Image size 2102x1736. Color fundus image: 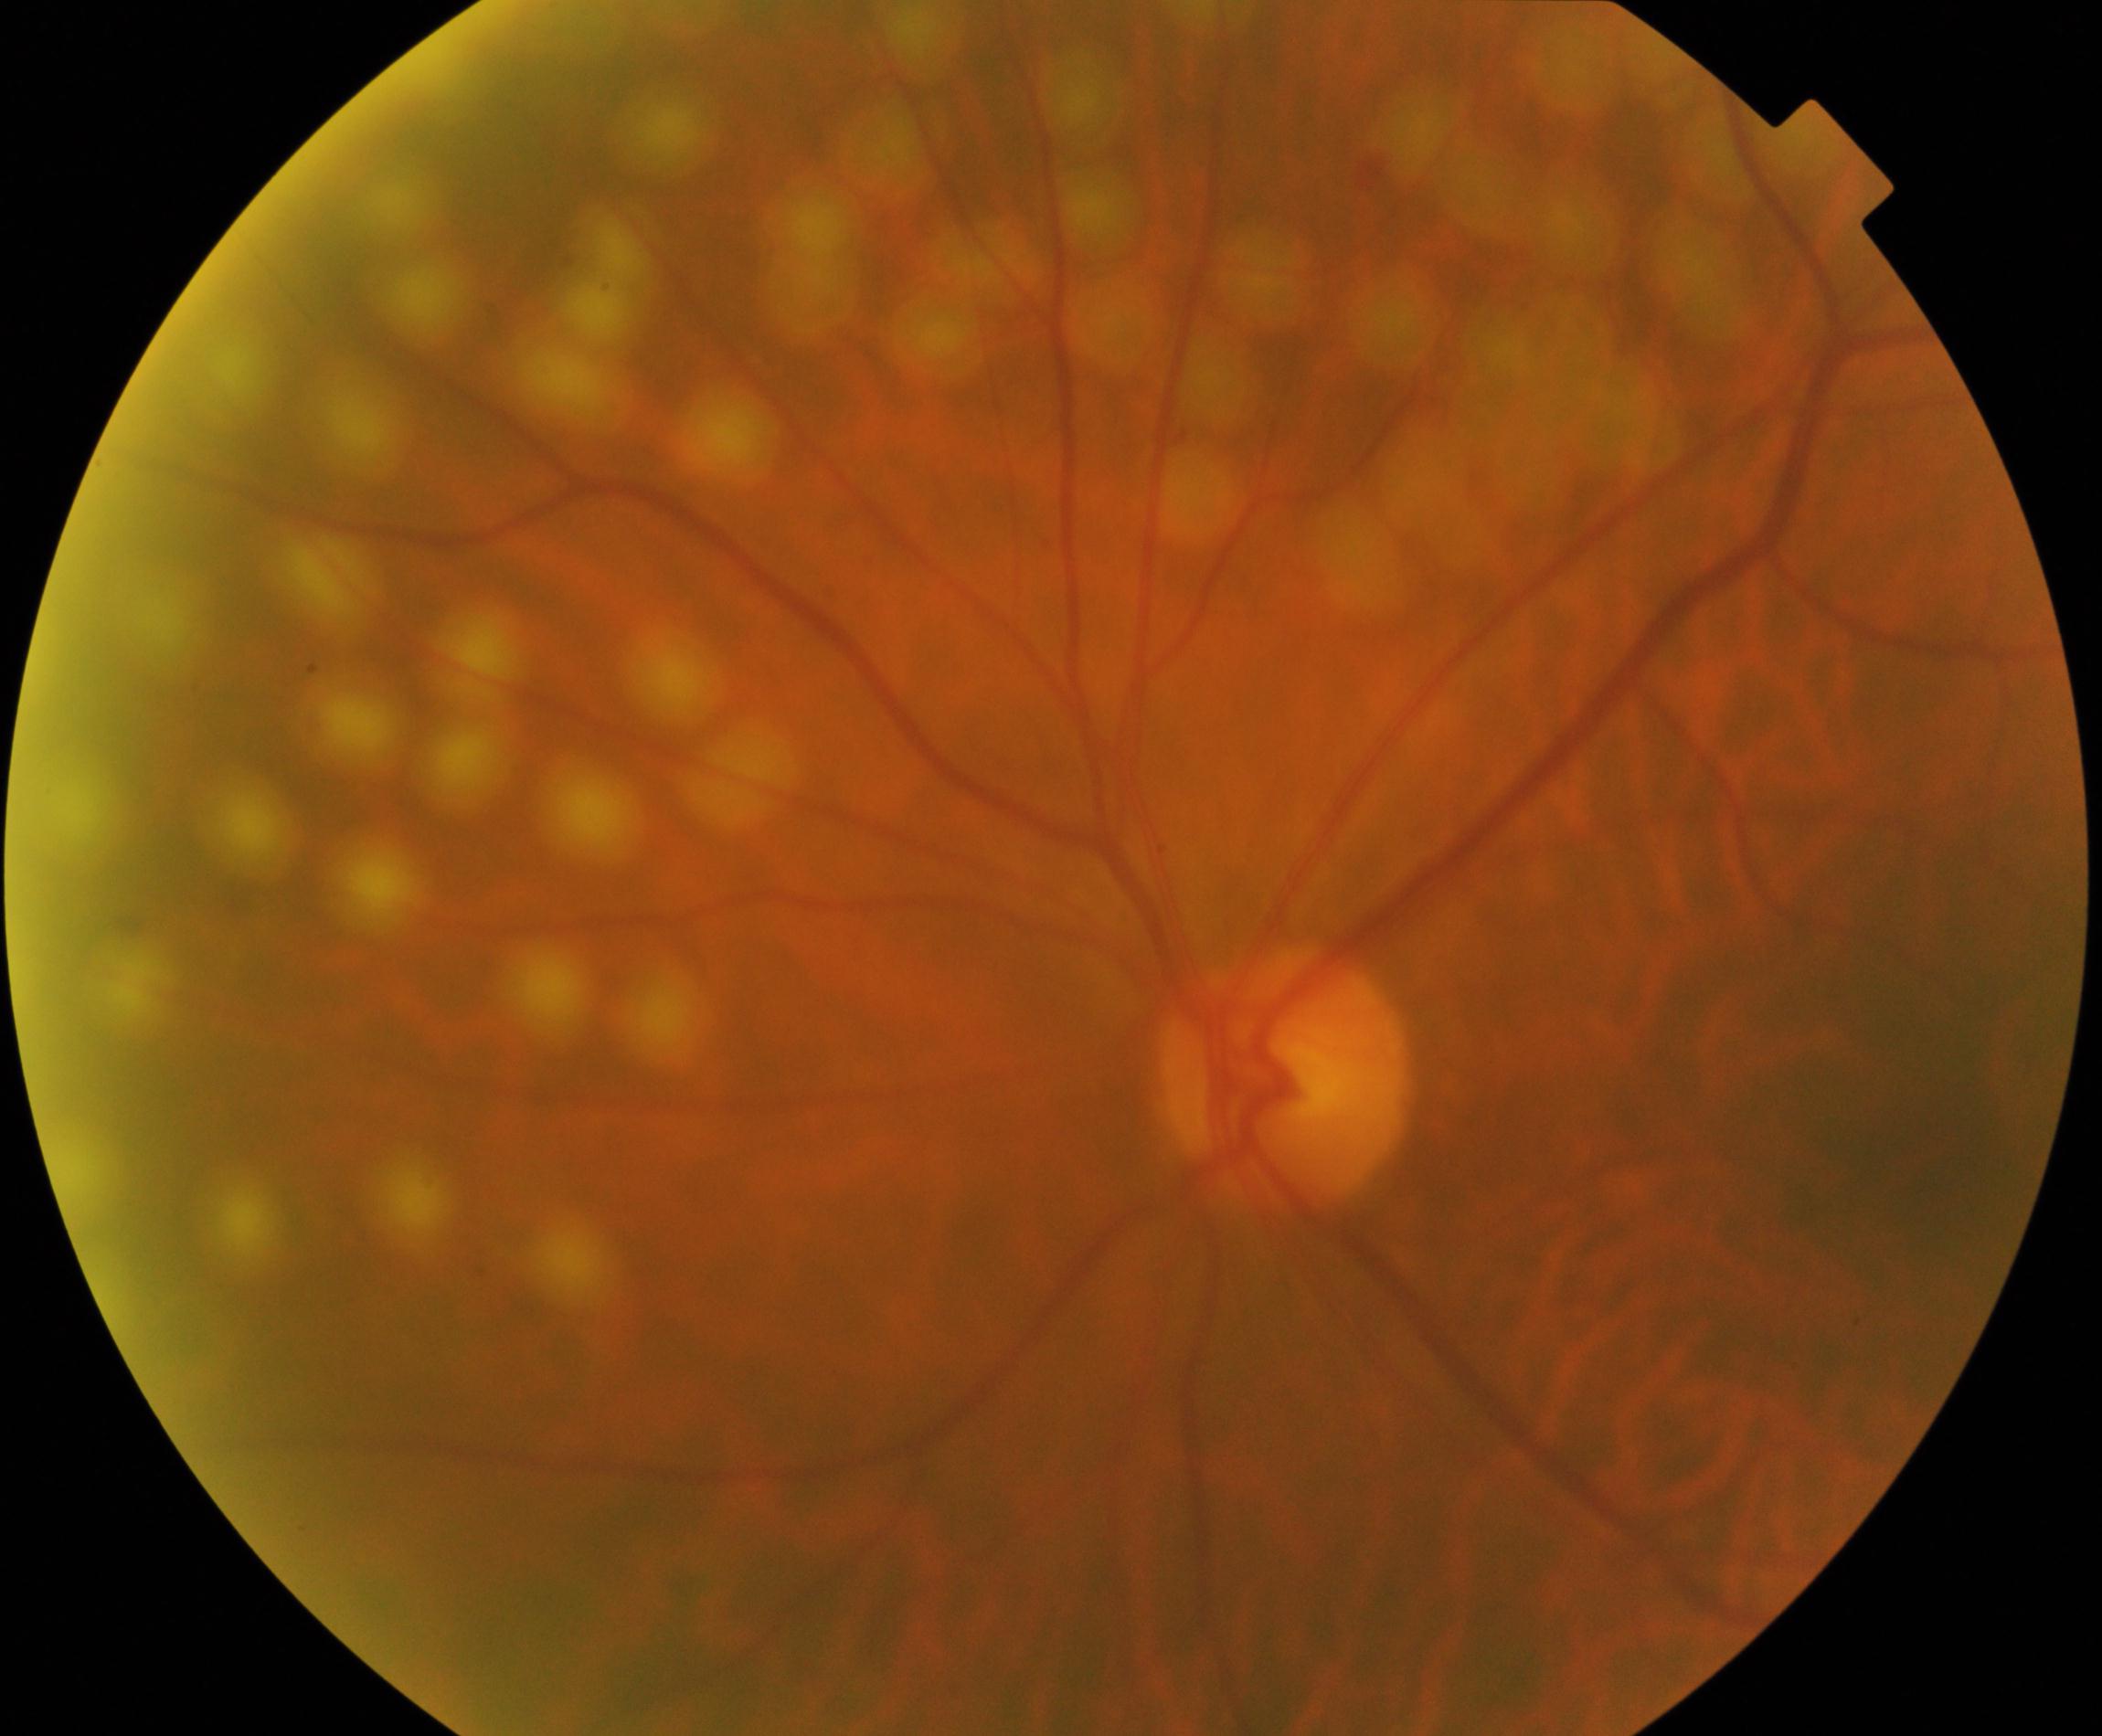

Impression: laser spots.